Wide-field fundus image from infant ROP screening. 1240 x 1240 pixels. 100° field of view (Phoenix ICON)
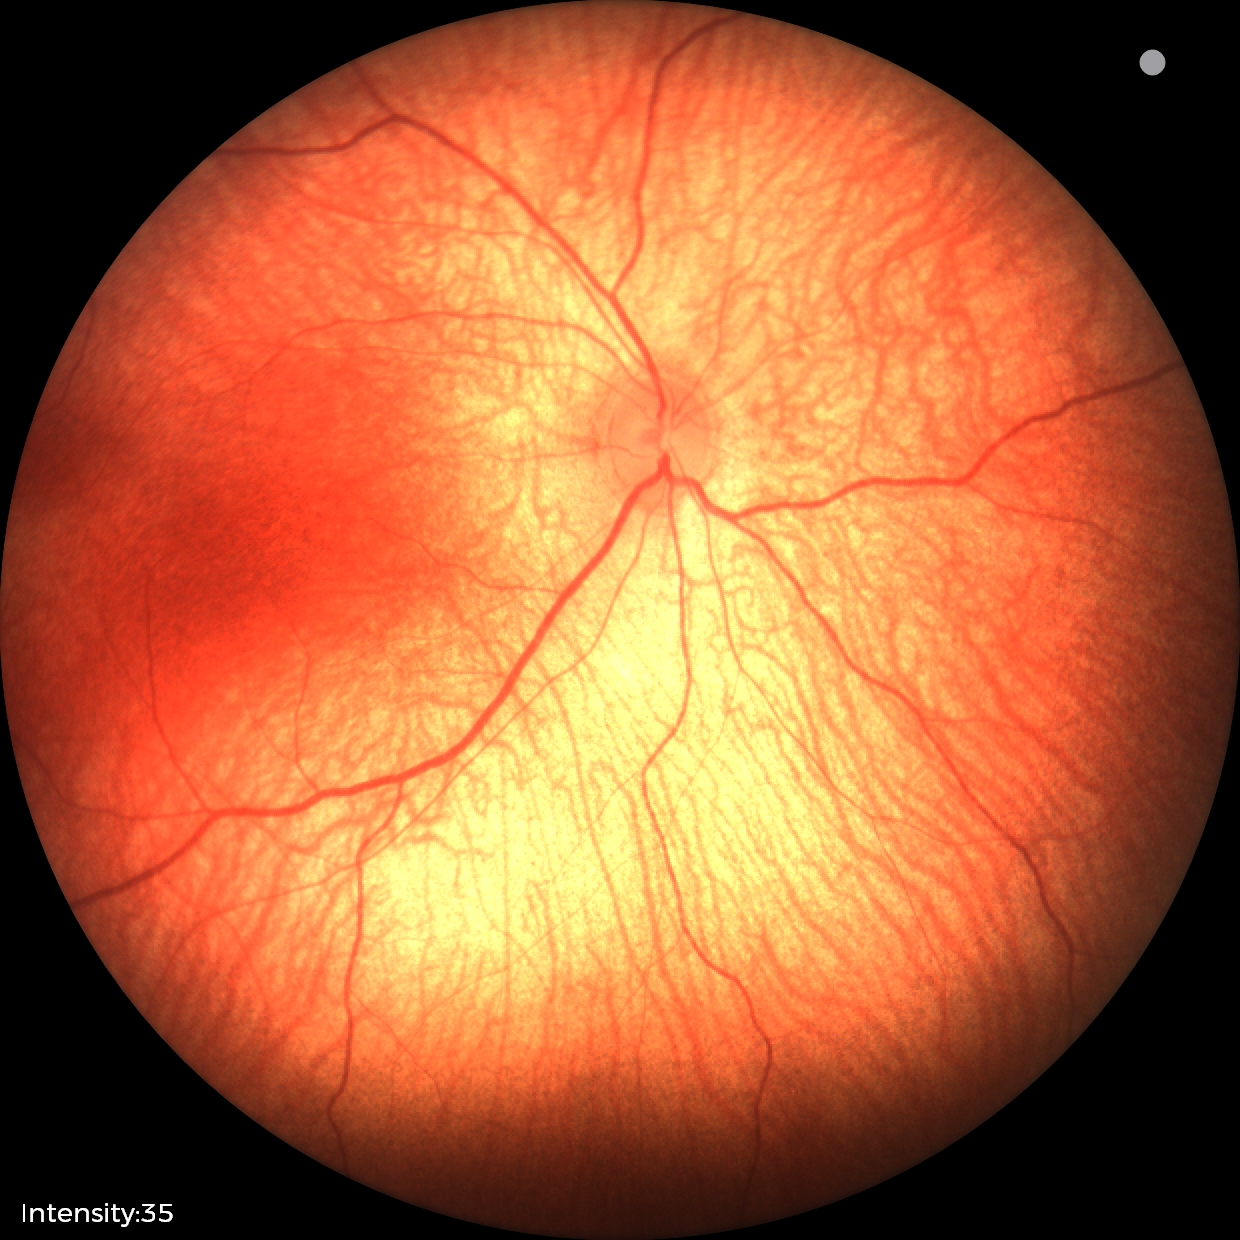
No retinal pathology identified on screening.